Wide-field fundus photograph from neonatal ROP screening: 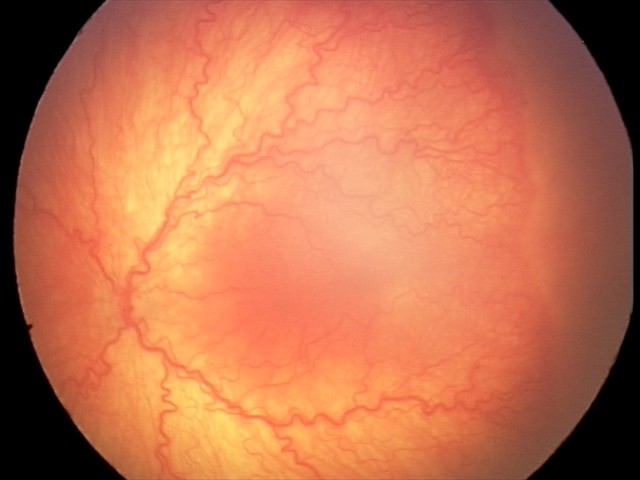
With plus disease. Diagnosis from this screening exam: aggressive retinopathy of prematurity.